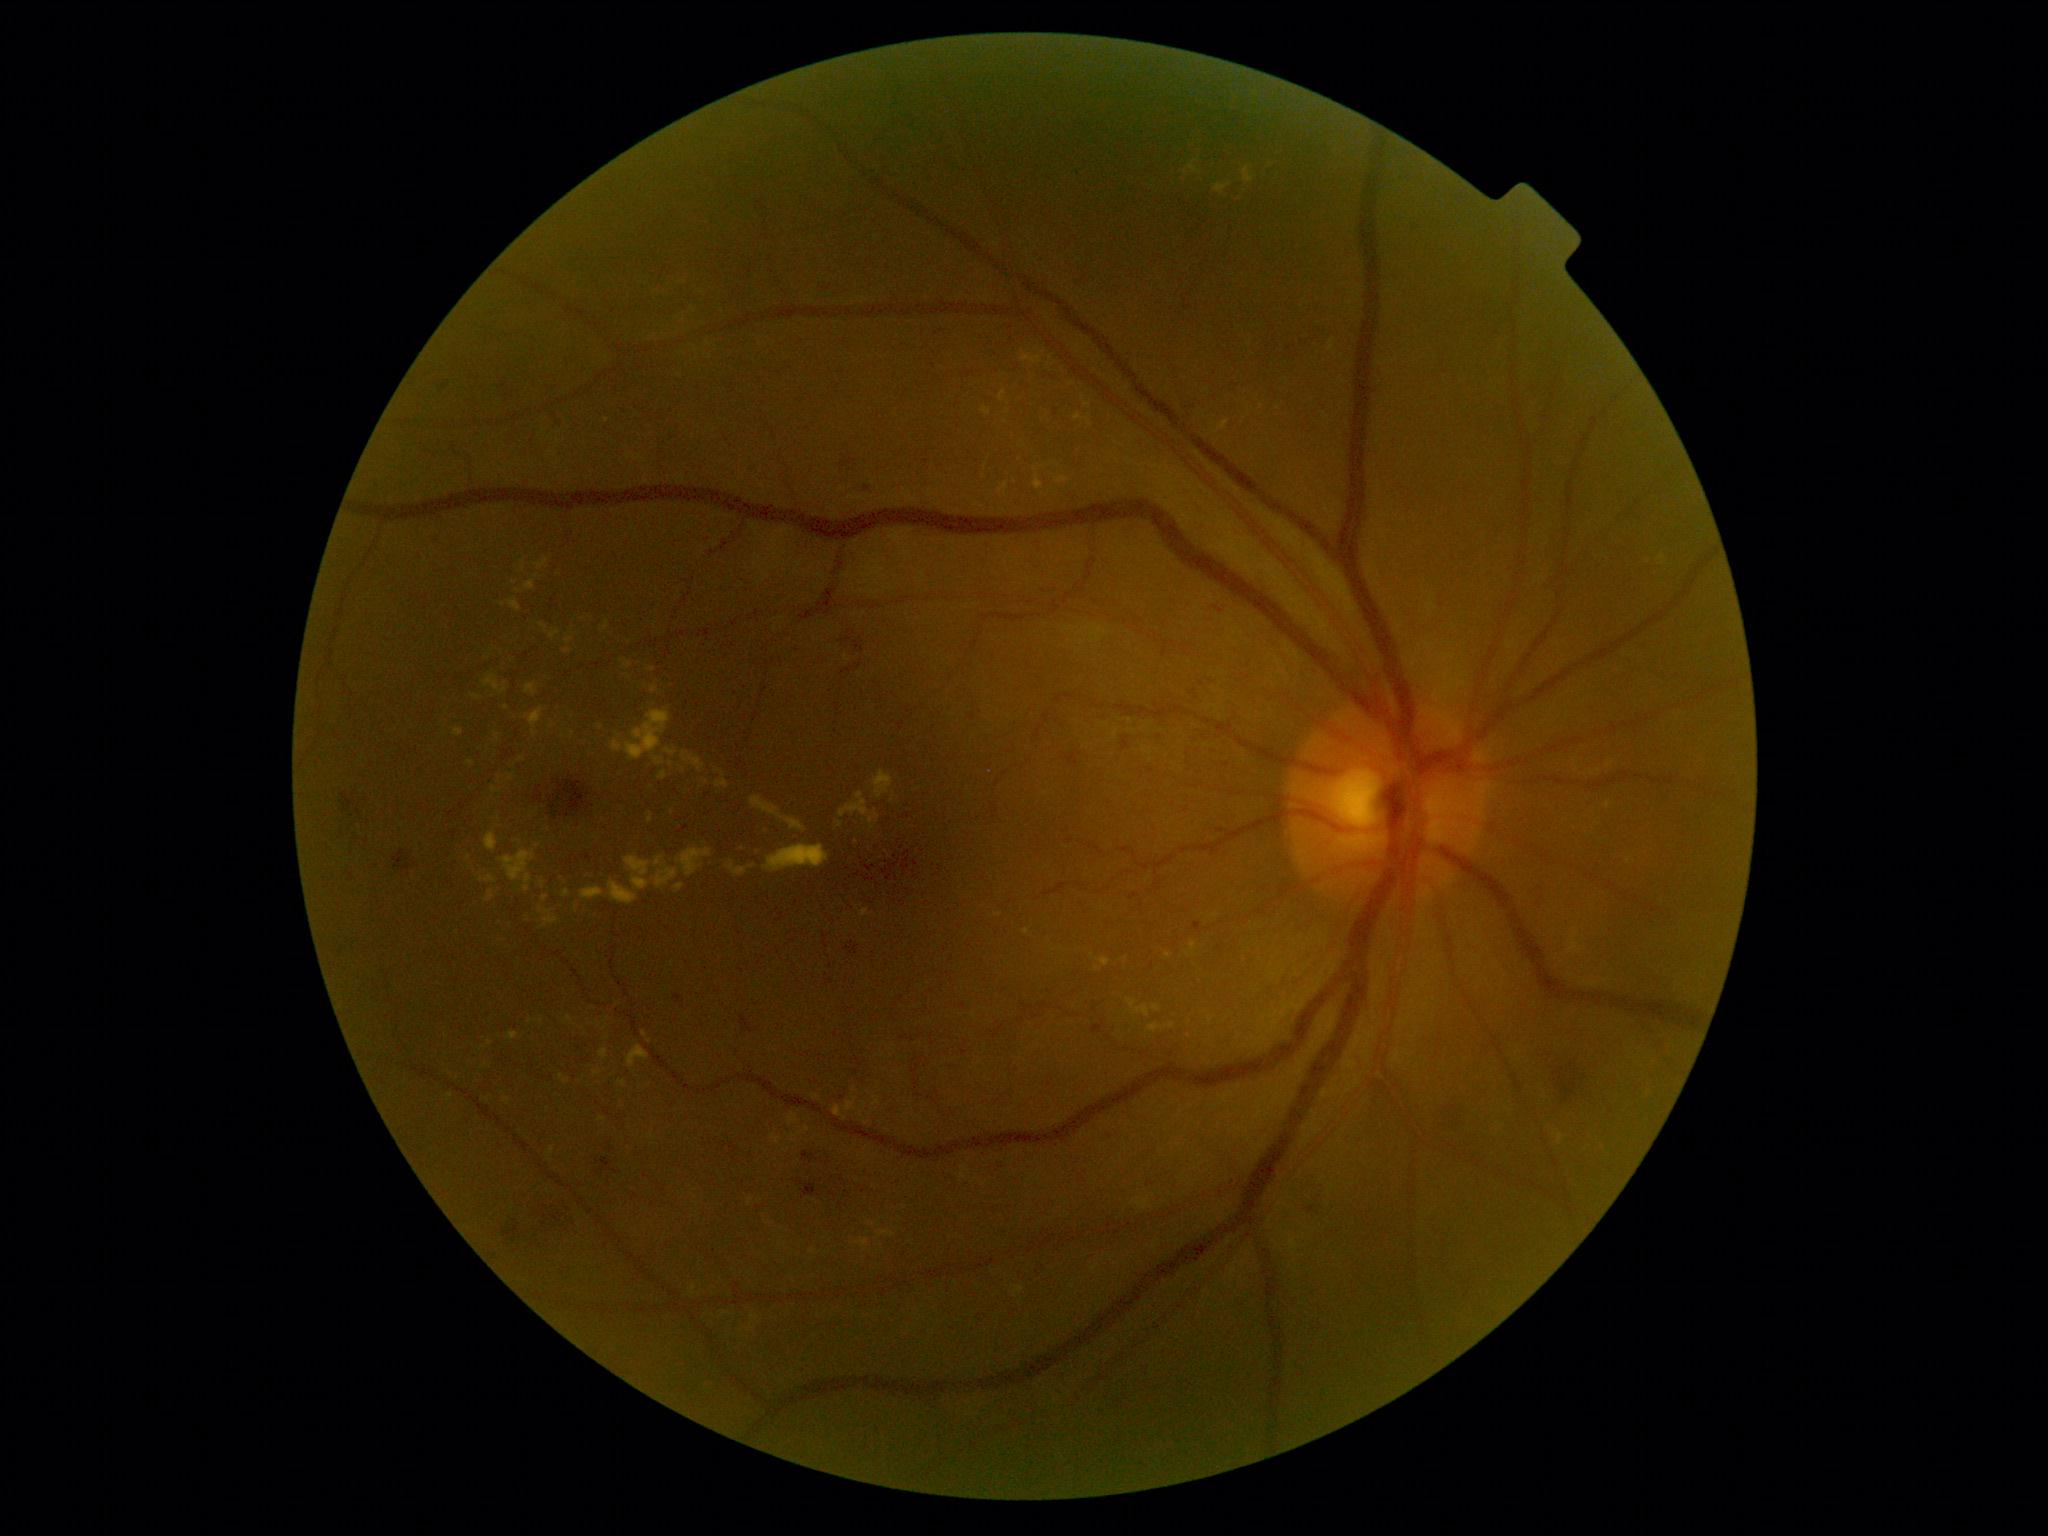

Diabetic retinopathy (DR) is moderate non-proliferative diabetic retinopathy (grade 2) — more than just microaneurysms but less than severe NPDR; non-proliferative diabetic retinopathy
Lesions identified (partial list):
* hard exudates (EXs) (partial): [982, 408, 992, 415], [1216, 421, 1230, 434], [521, 560, 525, 571], [664, 747, 677, 756], [999, 391, 1006, 402], [1153, 1005, 1161, 1012], [508, 1032, 519, 1041], [873, 770, 893, 799], [716, 779, 729, 789], [581, 886, 605, 901], [751, 796, 807, 832]
* Small EXs near (1050; 359), (650; 1041), (1216; 916), (705; 782), (840; 825), (499; 783), (469; 858)
* hemorrhages (HEs) (partial): [840, 637, 852, 644], [1302, 328, 1339, 358], [595, 1158, 621, 1174], [902, 813, 910, 819], [741, 1015, 753, 1032], [803, 1151, 816, 1163], [1438, 1102, 1482, 1143], [1406, 219, 1422, 235], [502, 1223, 528, 1244], [796, 1178, 804, 1186], [393, 850, 410, 872], [1122, 739, 1130, 752]
* Small HEs near (611; 1150), (864; 1192)